Color fundus image, acquired with a NIDEK AFC-230: 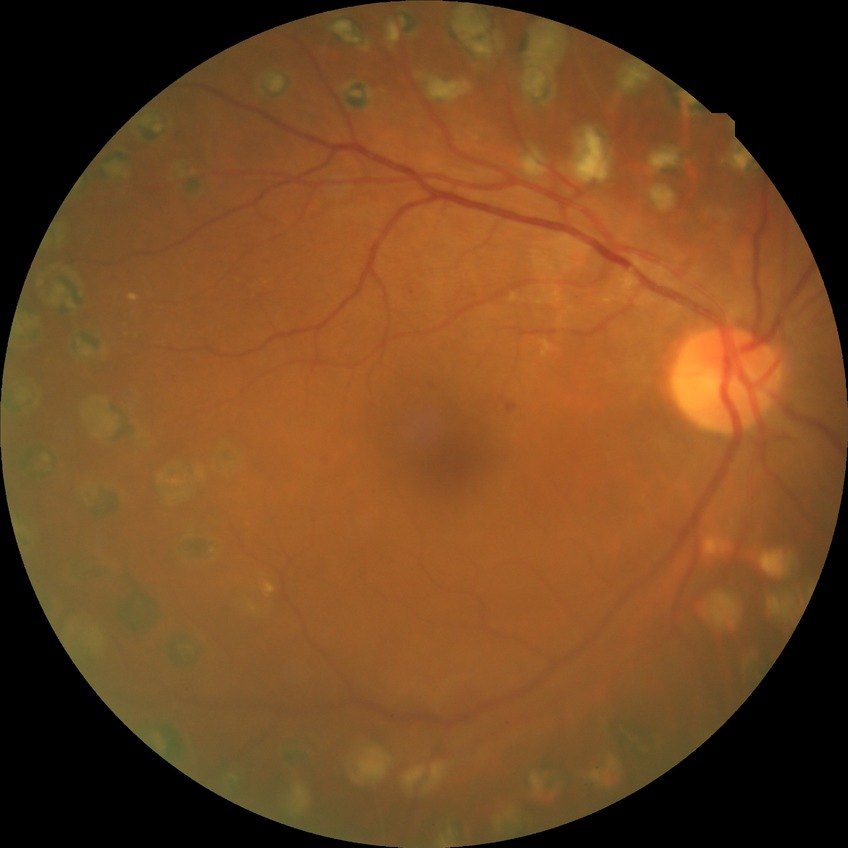 Diabetic retinopathy grade is proliferative diabetic retinopathy.